Refraction: +2.25 -2.25 × 90°; axial length (AL): 24.07 mm.
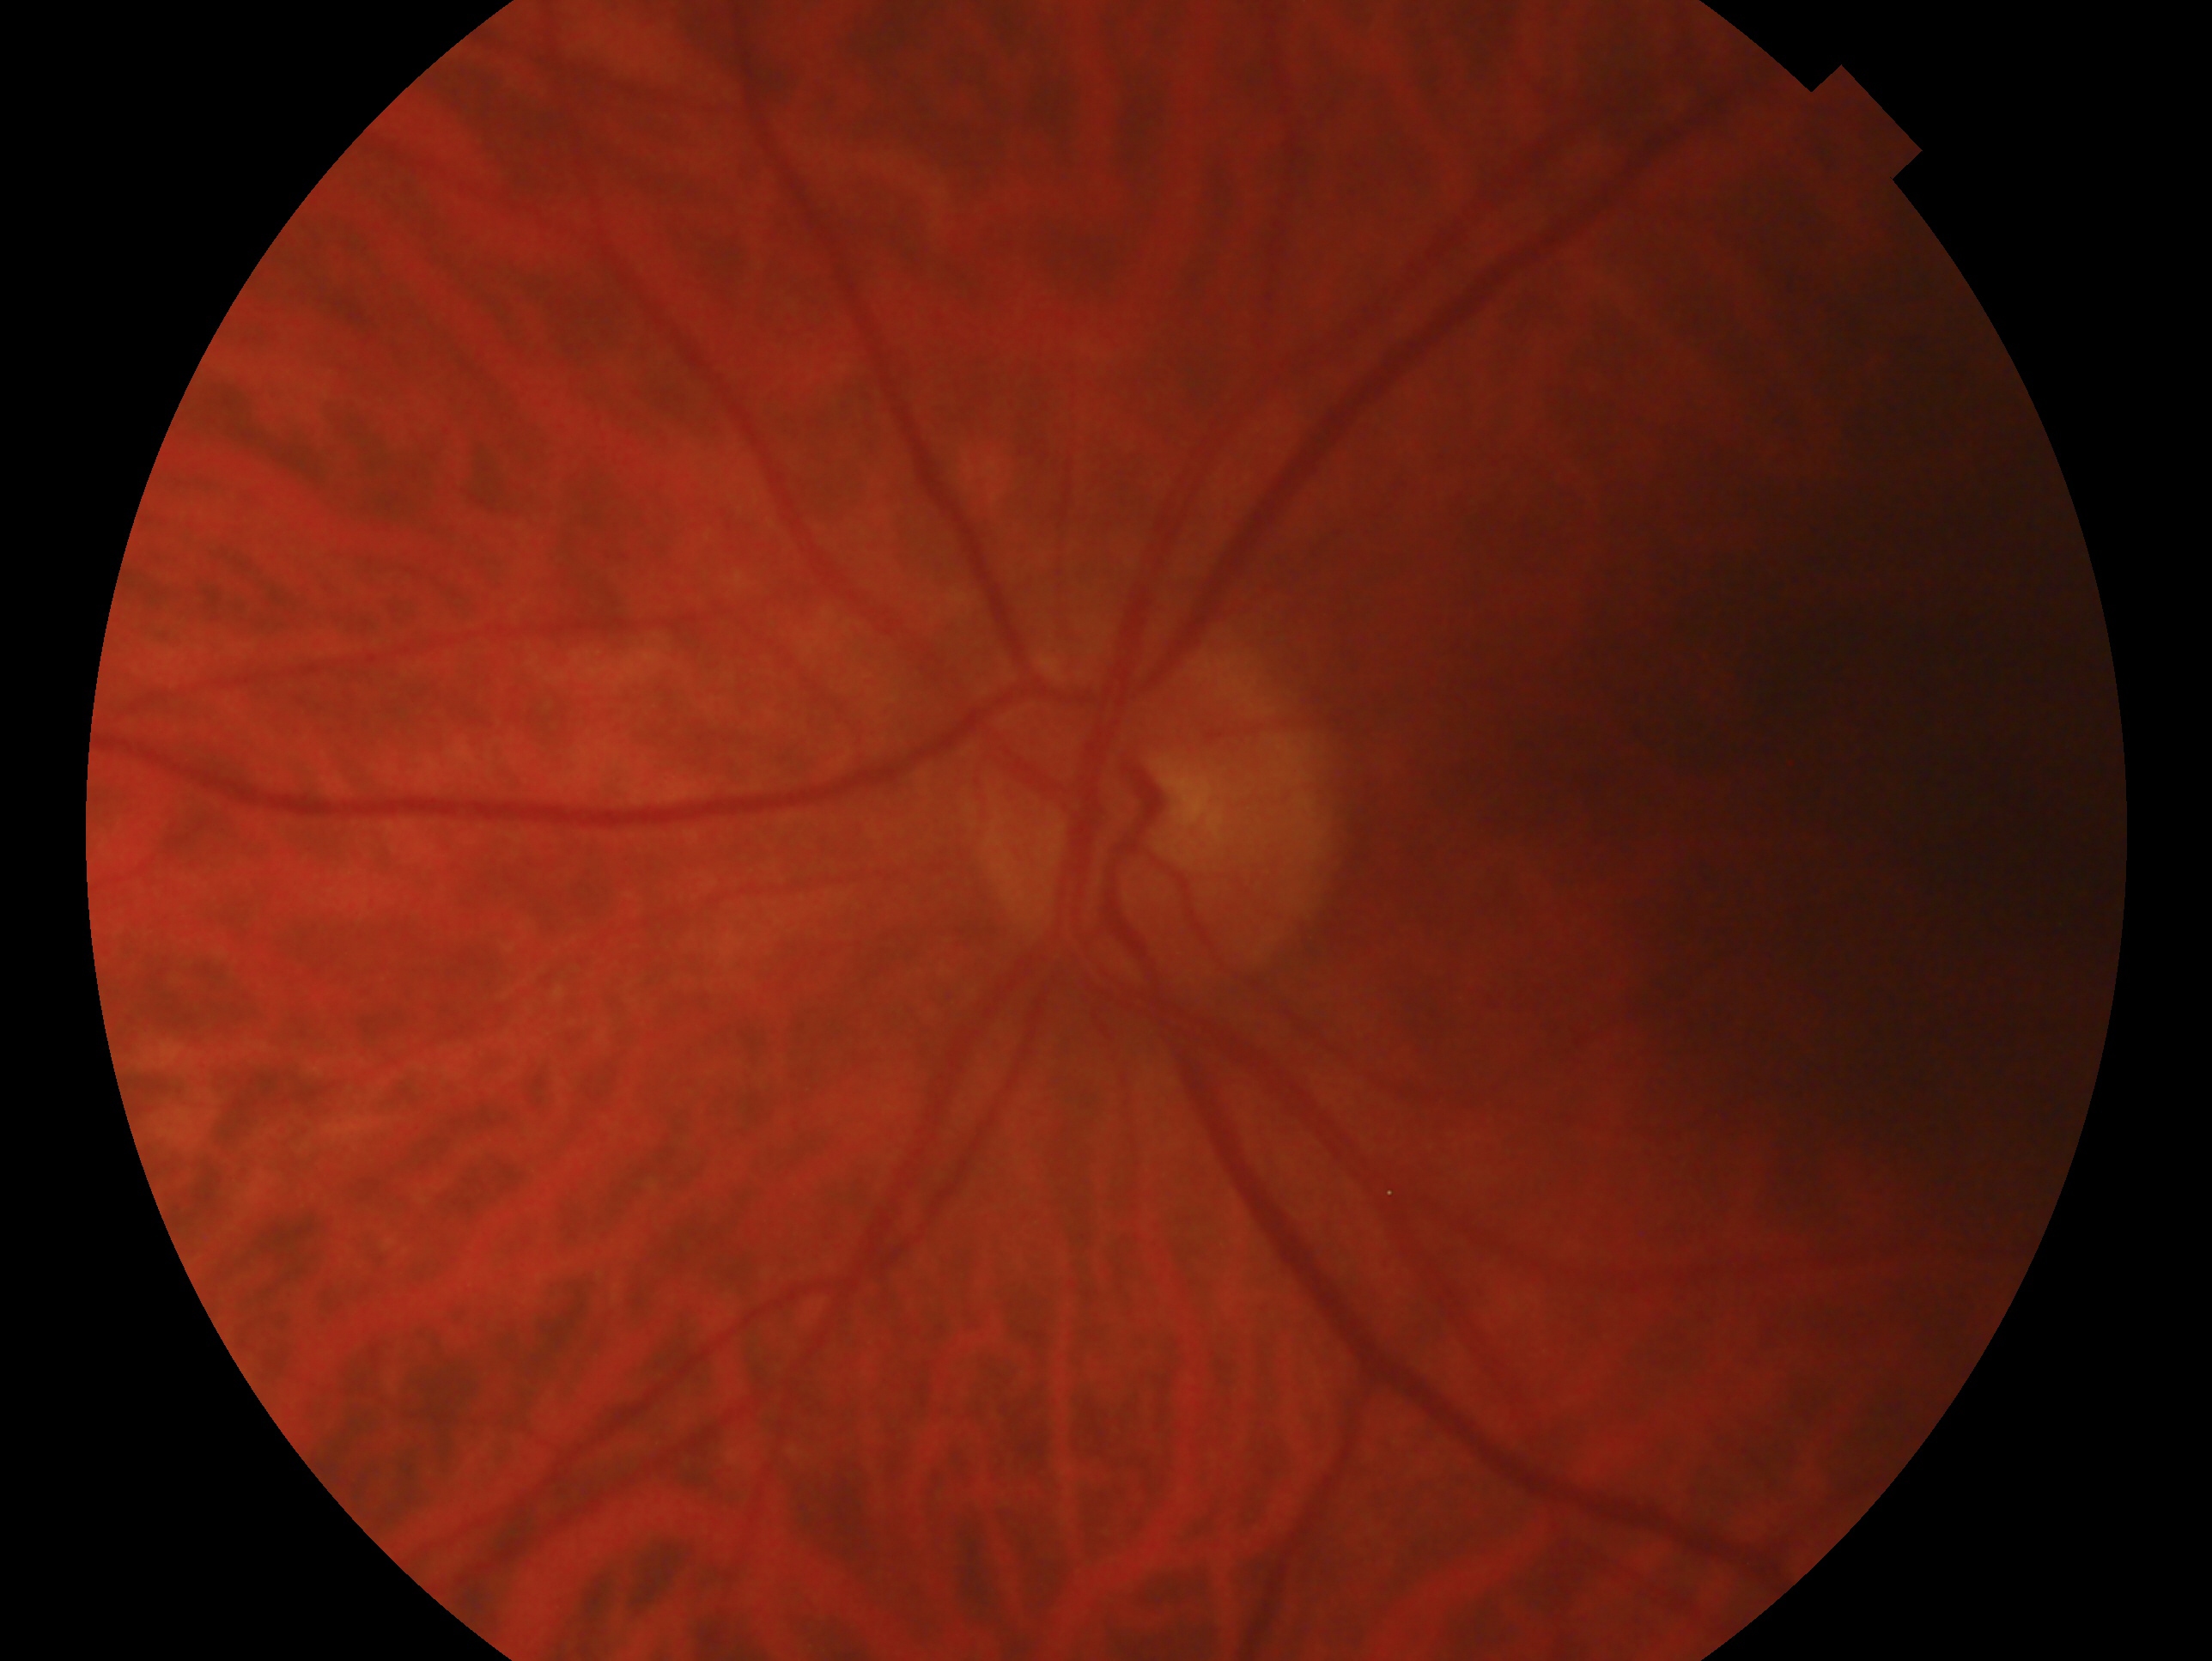
Eye: OS.
Impression: glaucomatous optic neuropathy.